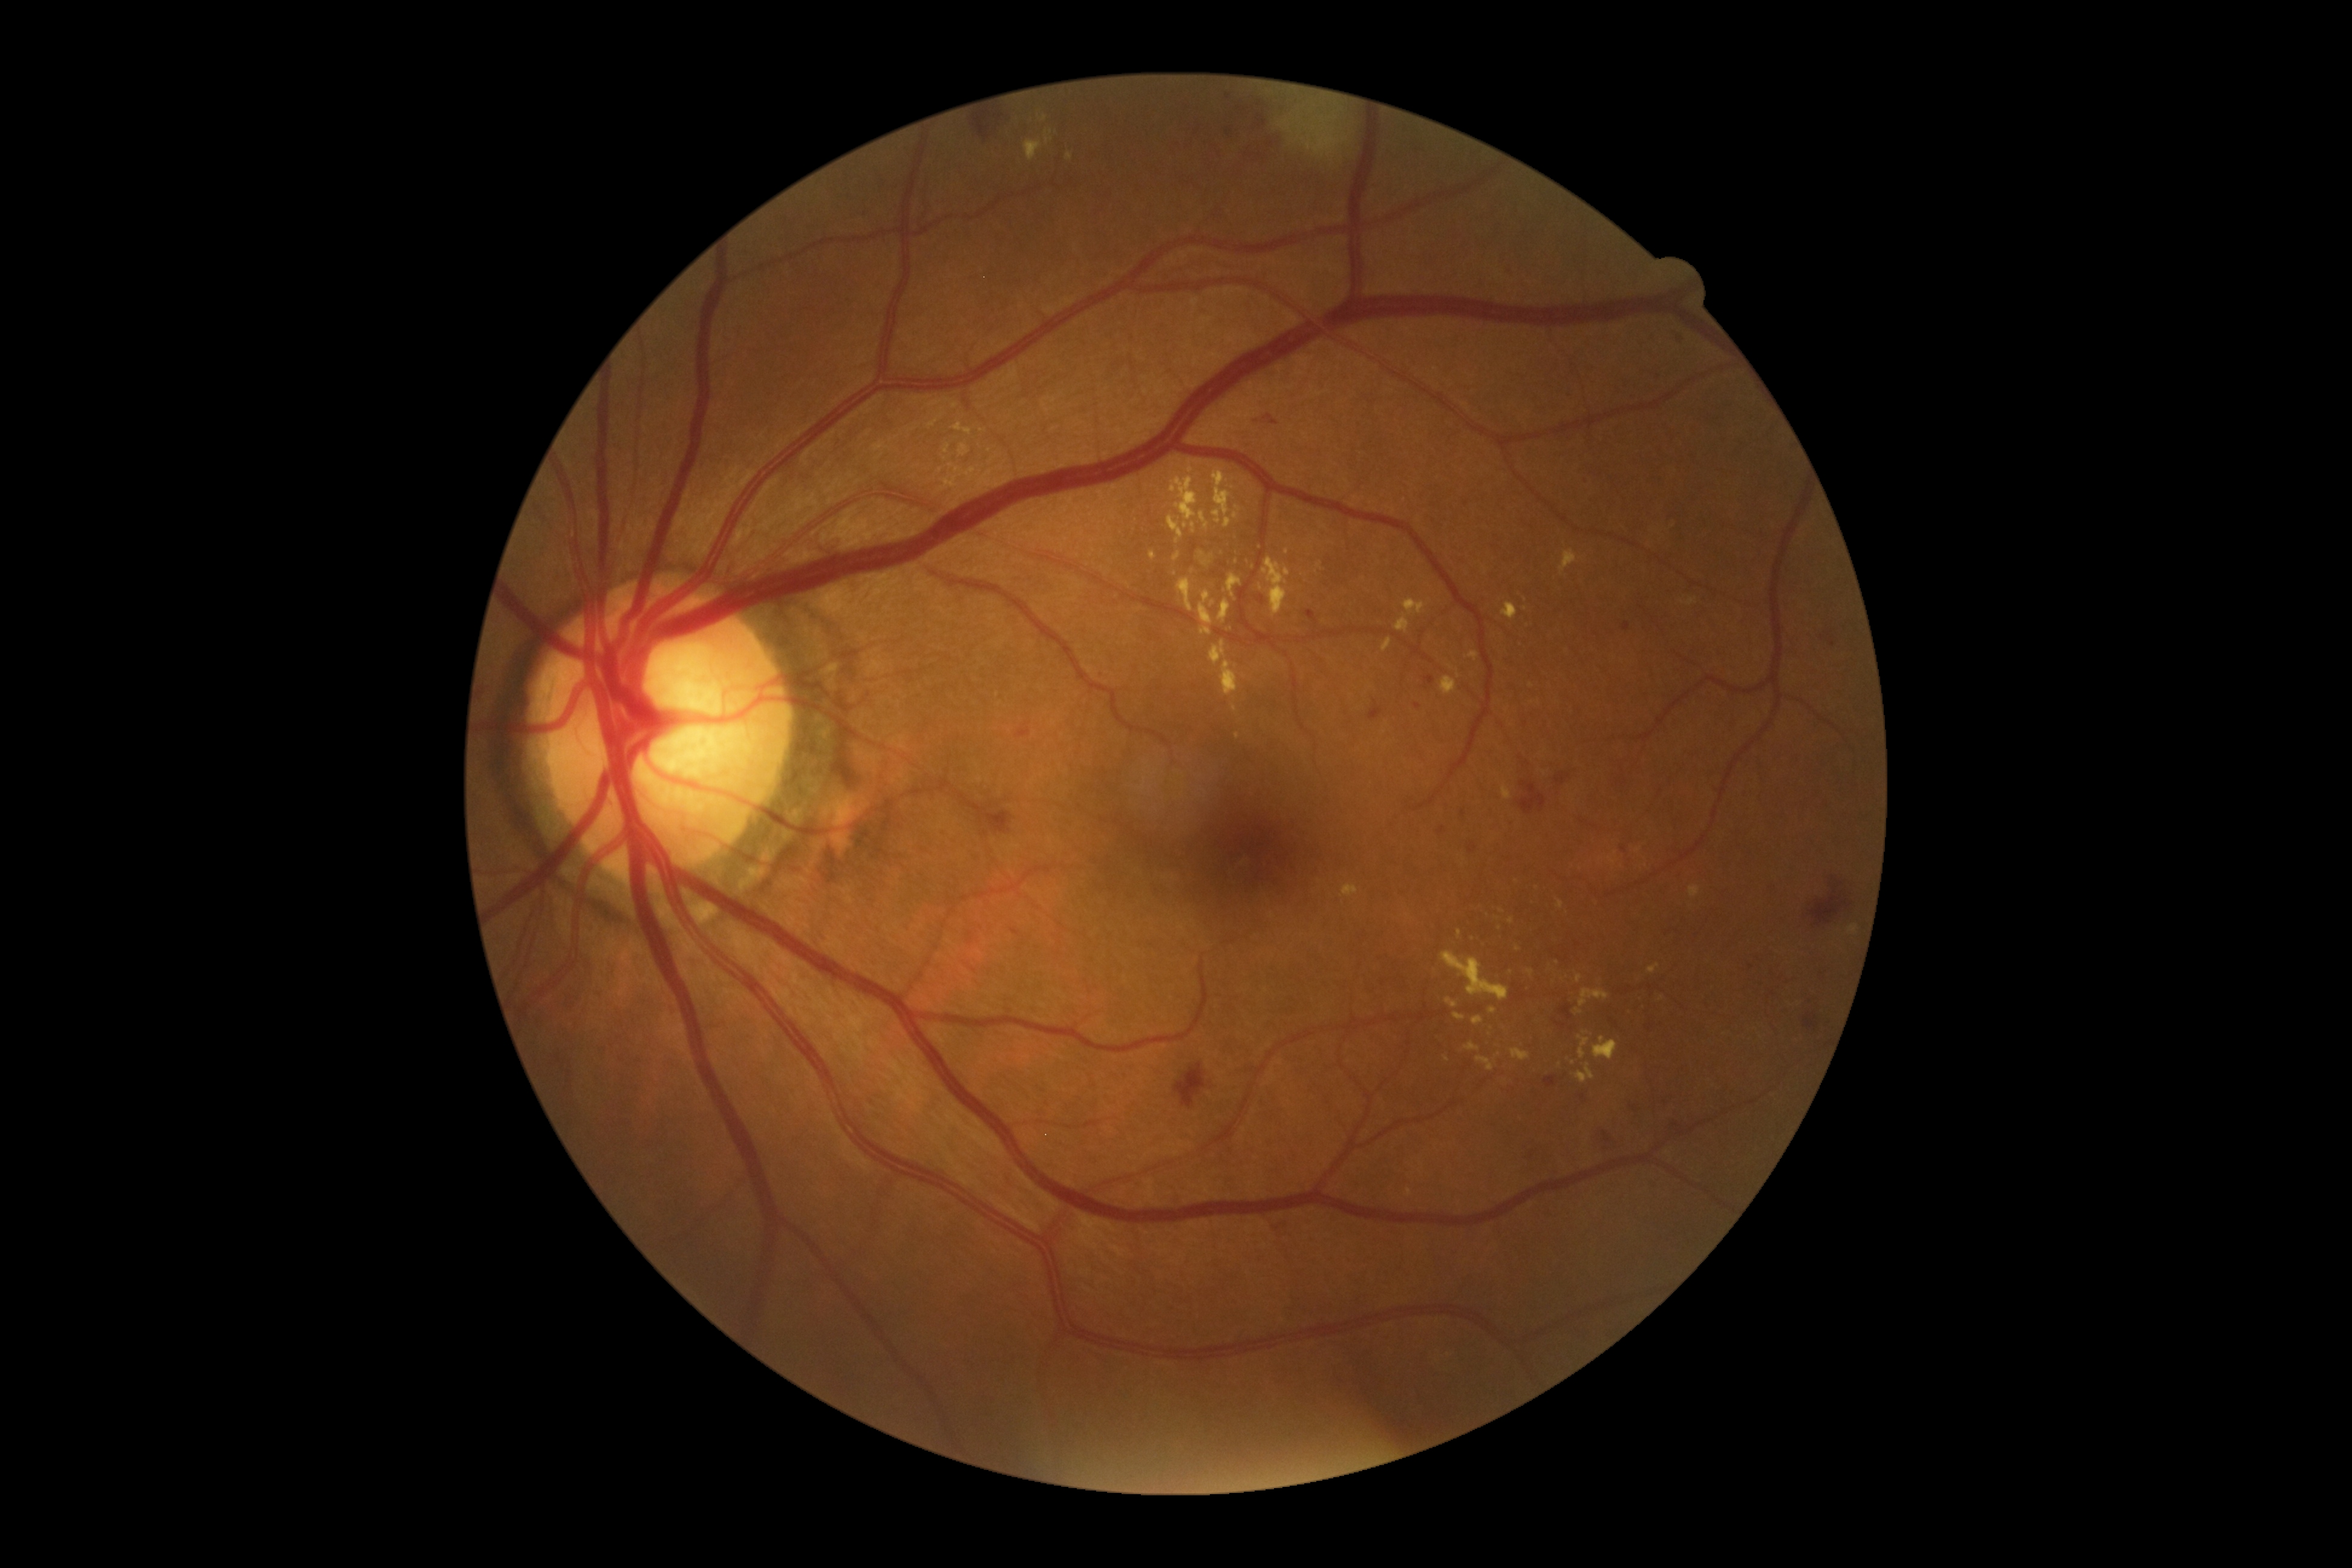

Retinopathy: moderate NPDR (grade 2) — more than just microaneurysms but less than severe NPDR.
Hard exudates (partial list) at [1457, 930, 1462, 938] | [1177, 578, 1194, 612] | [1224, 518, 1231, 528] | [1472, 1016, 1484, 1025] | [1045, 130, 1054, 145] | [1444, 1054, 1451, 1062] | [1198, 551, 1206, 560] | [1025, 139, 1044, 162] | [1342, 884, 1359, 896] | [1213, 471, 1231, 523] | [1439, 677, 1456, 695].
Hard exudates (small, approximate centers) near (1044, 119) | (1234, 708) | (1502, 911) | (1236, 561) | (1585, 1032).